Wide-field fundus image from infant ROP screening; Clarity RetCam 3, 130° FOV.
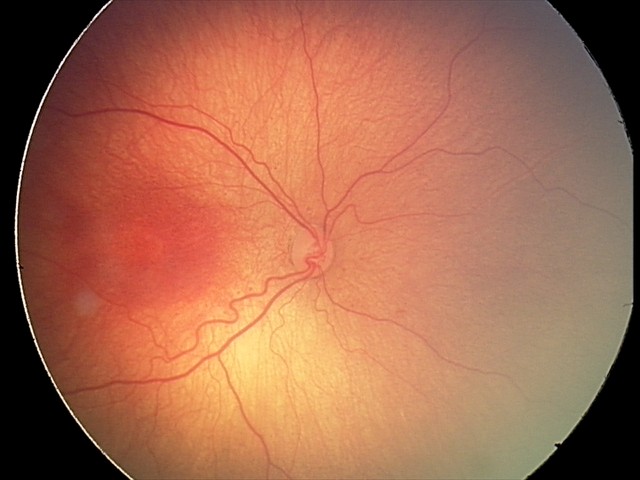

Assessment = ROP stage 2